Captured with the Phoenix ICON (100° field of view) · infant wide-field fundus photograph
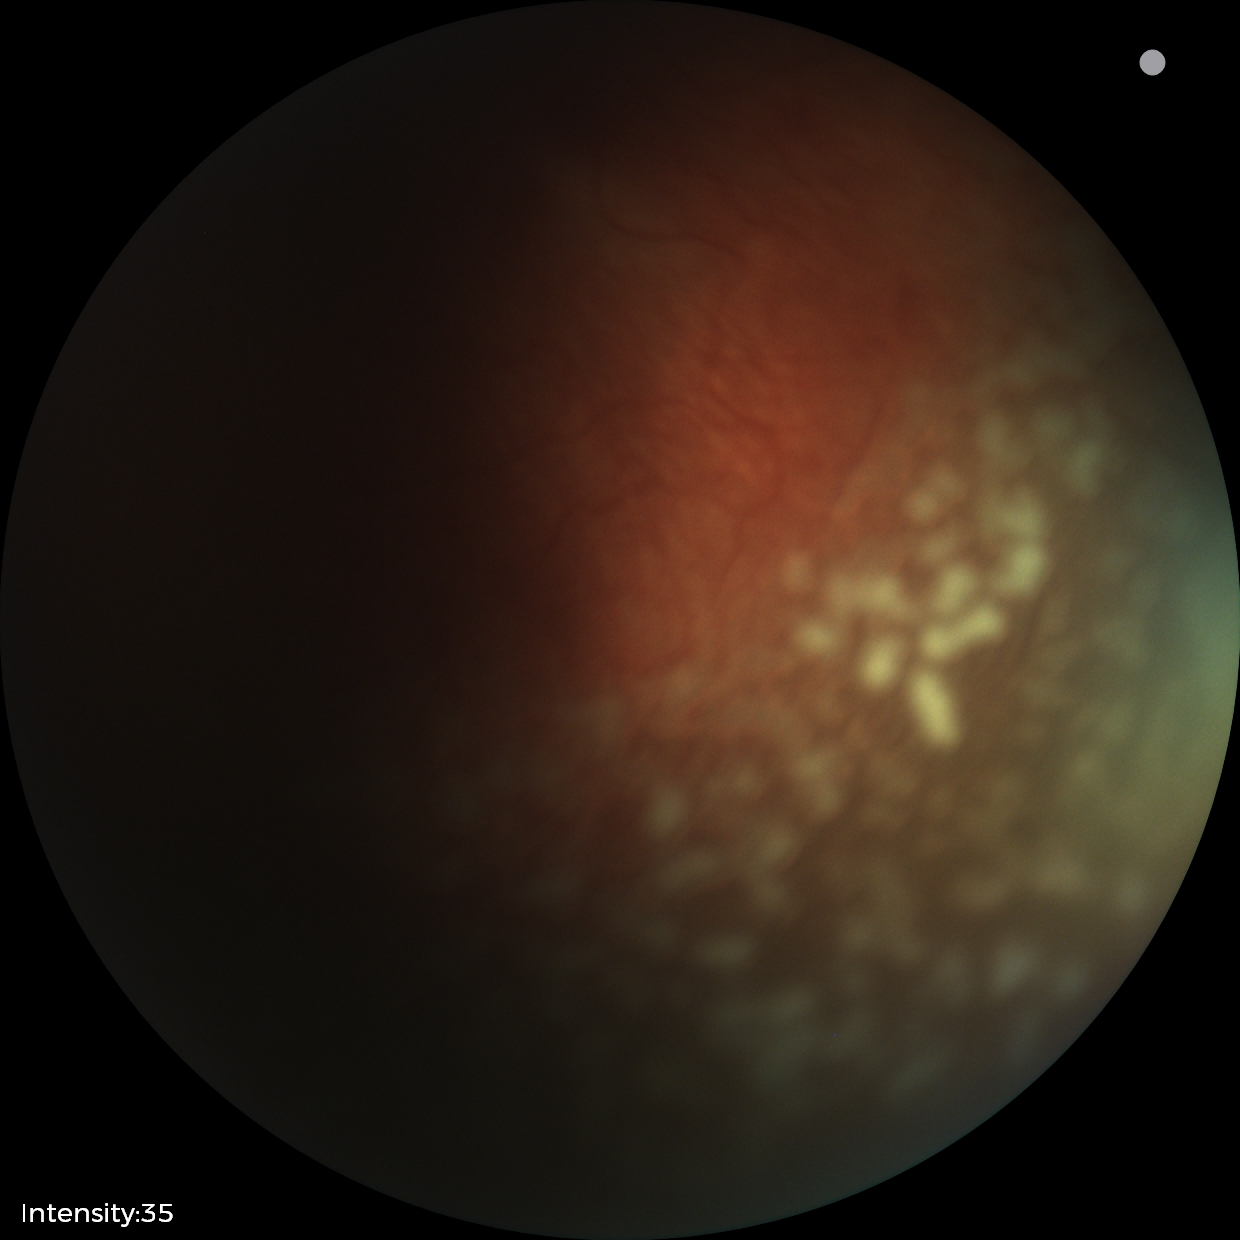
Screening diagnosis: ROP stage 2 | plus disease.